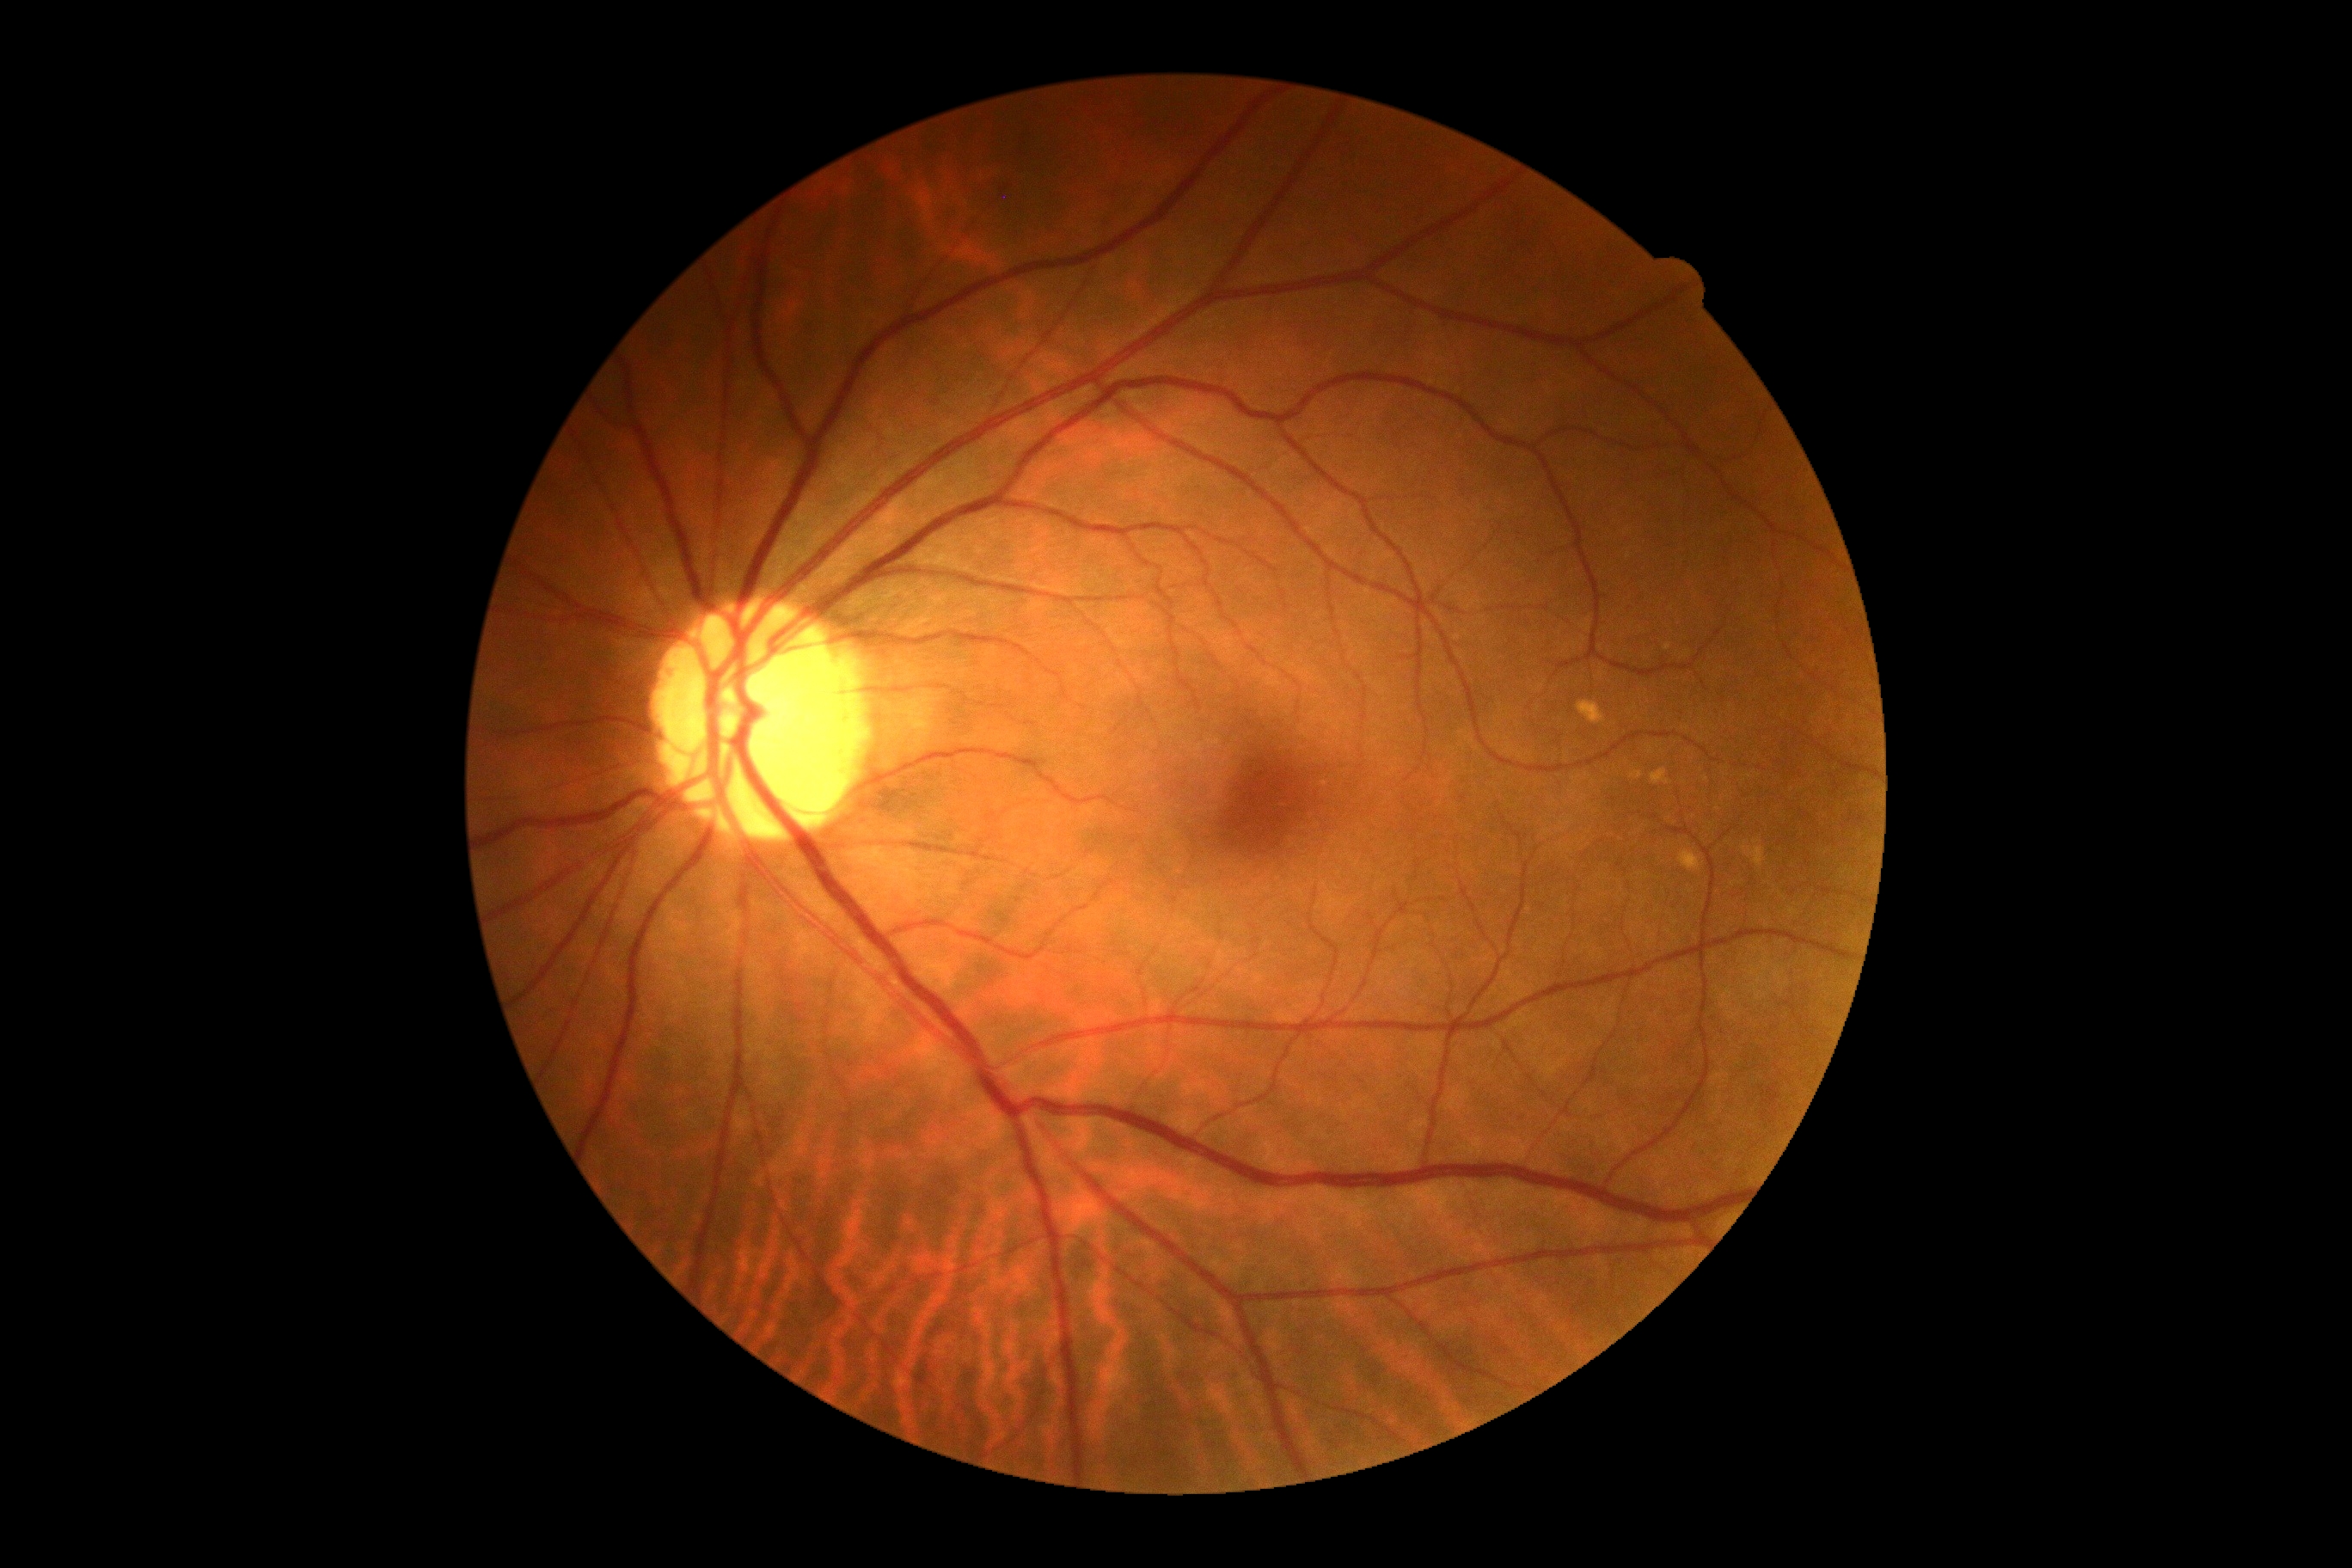 Findings:
• diabetic retinopathy grade — 0 (no apparent retinopathy)